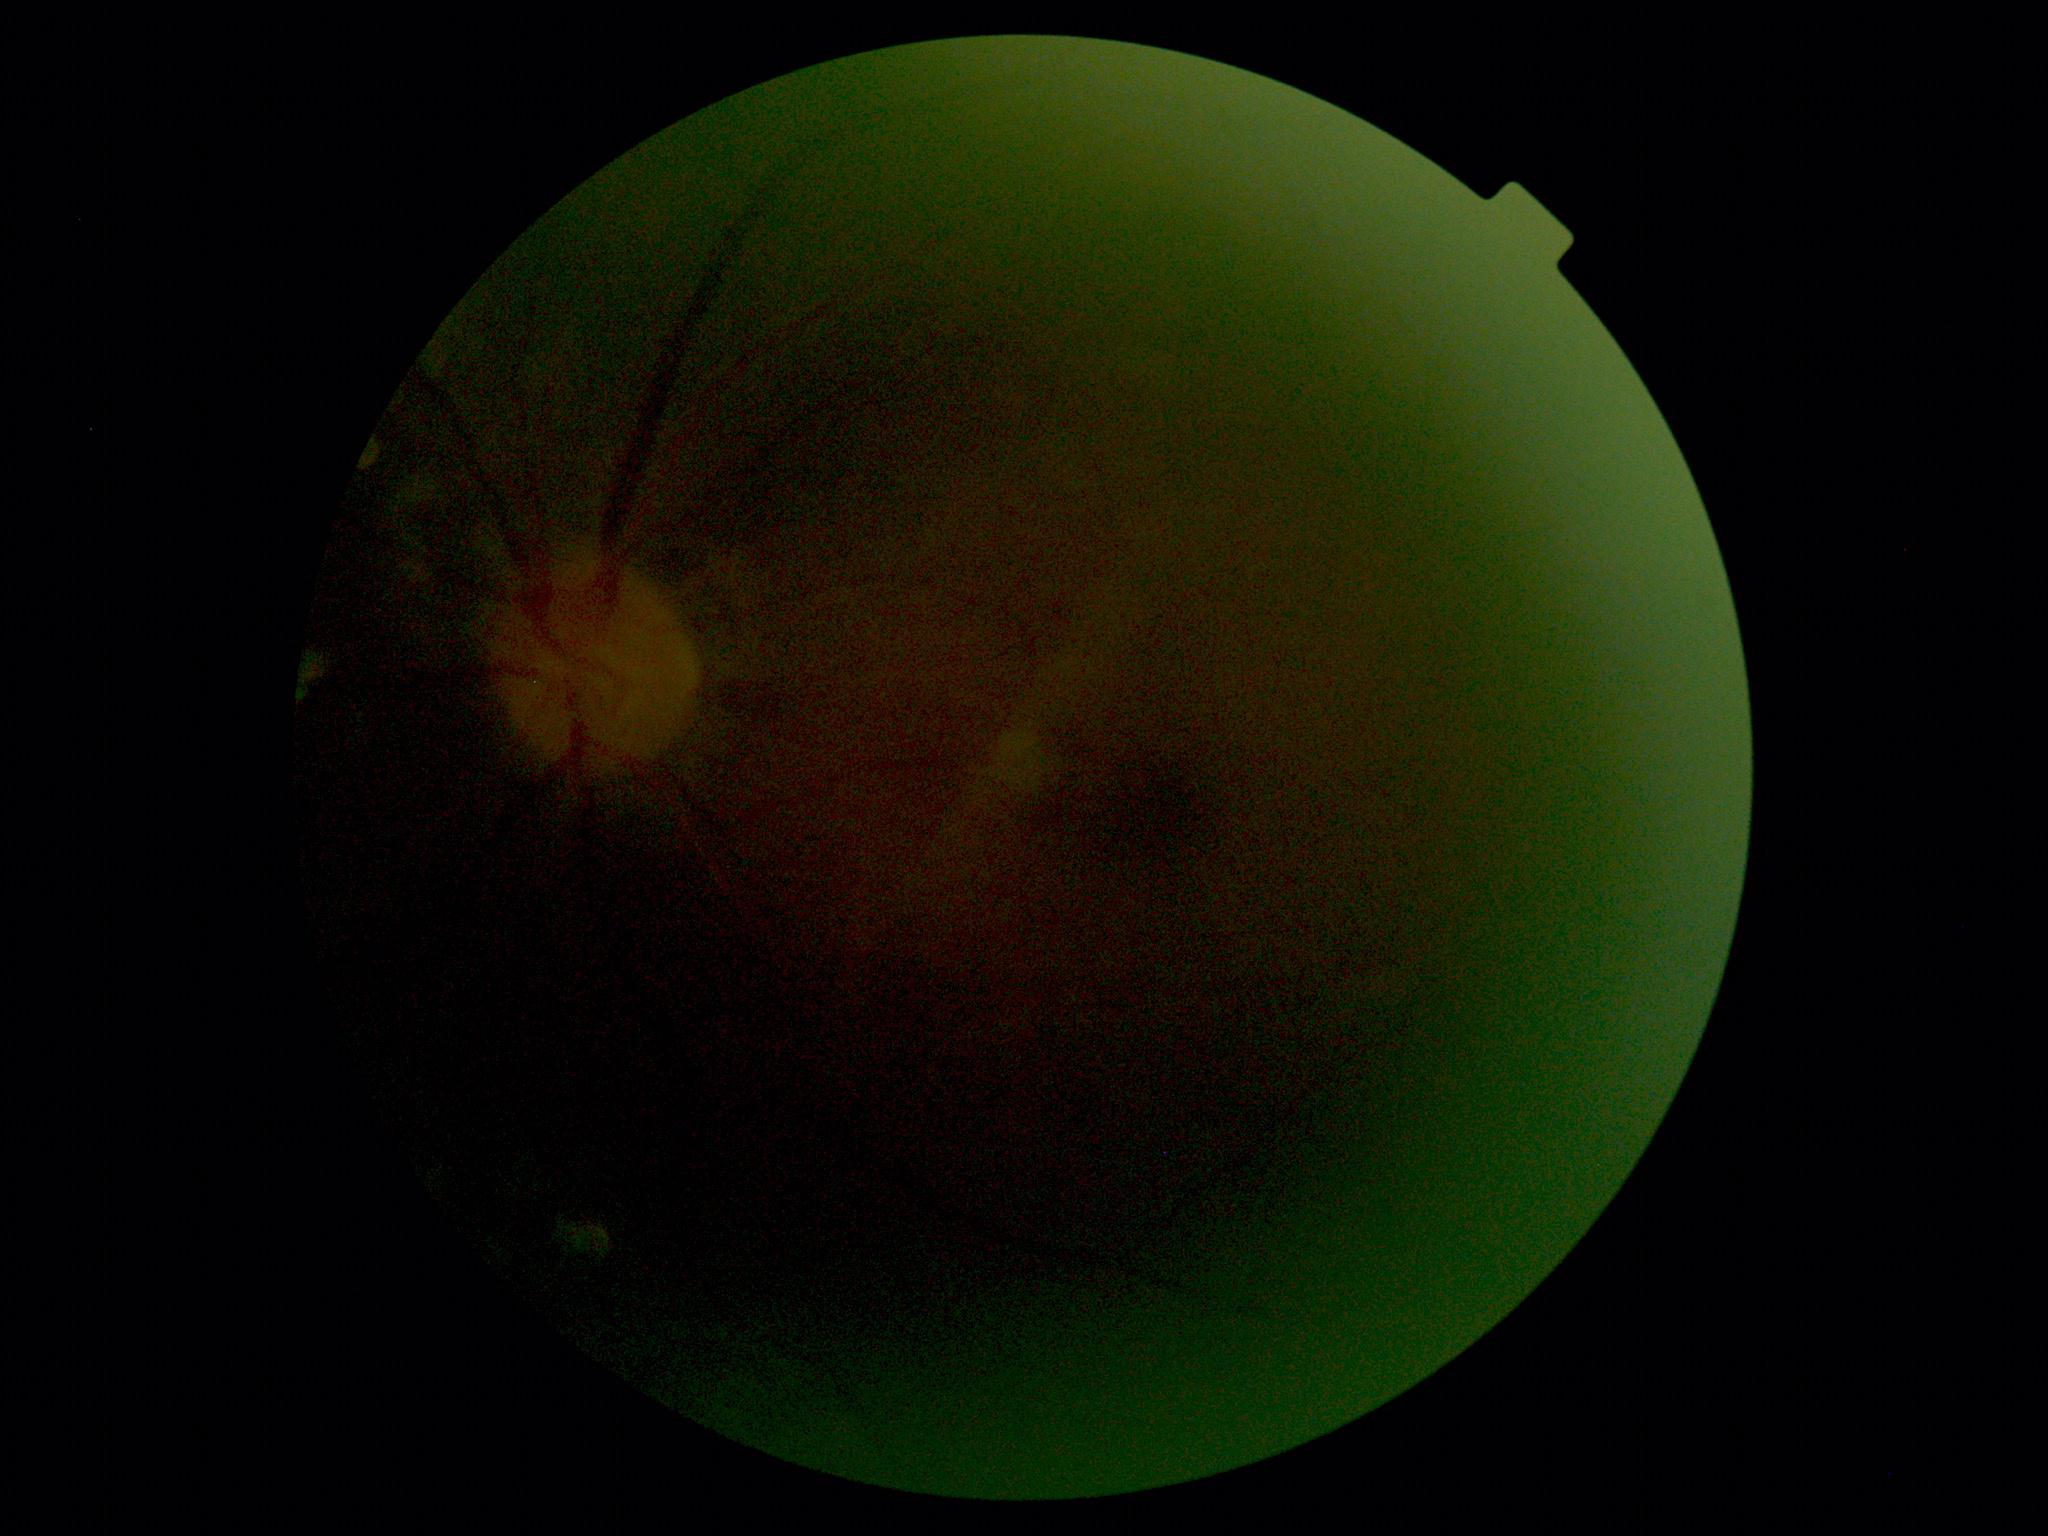 * image quality: too poor for DR grading
* DR severity: ungradable